Fundus photo.
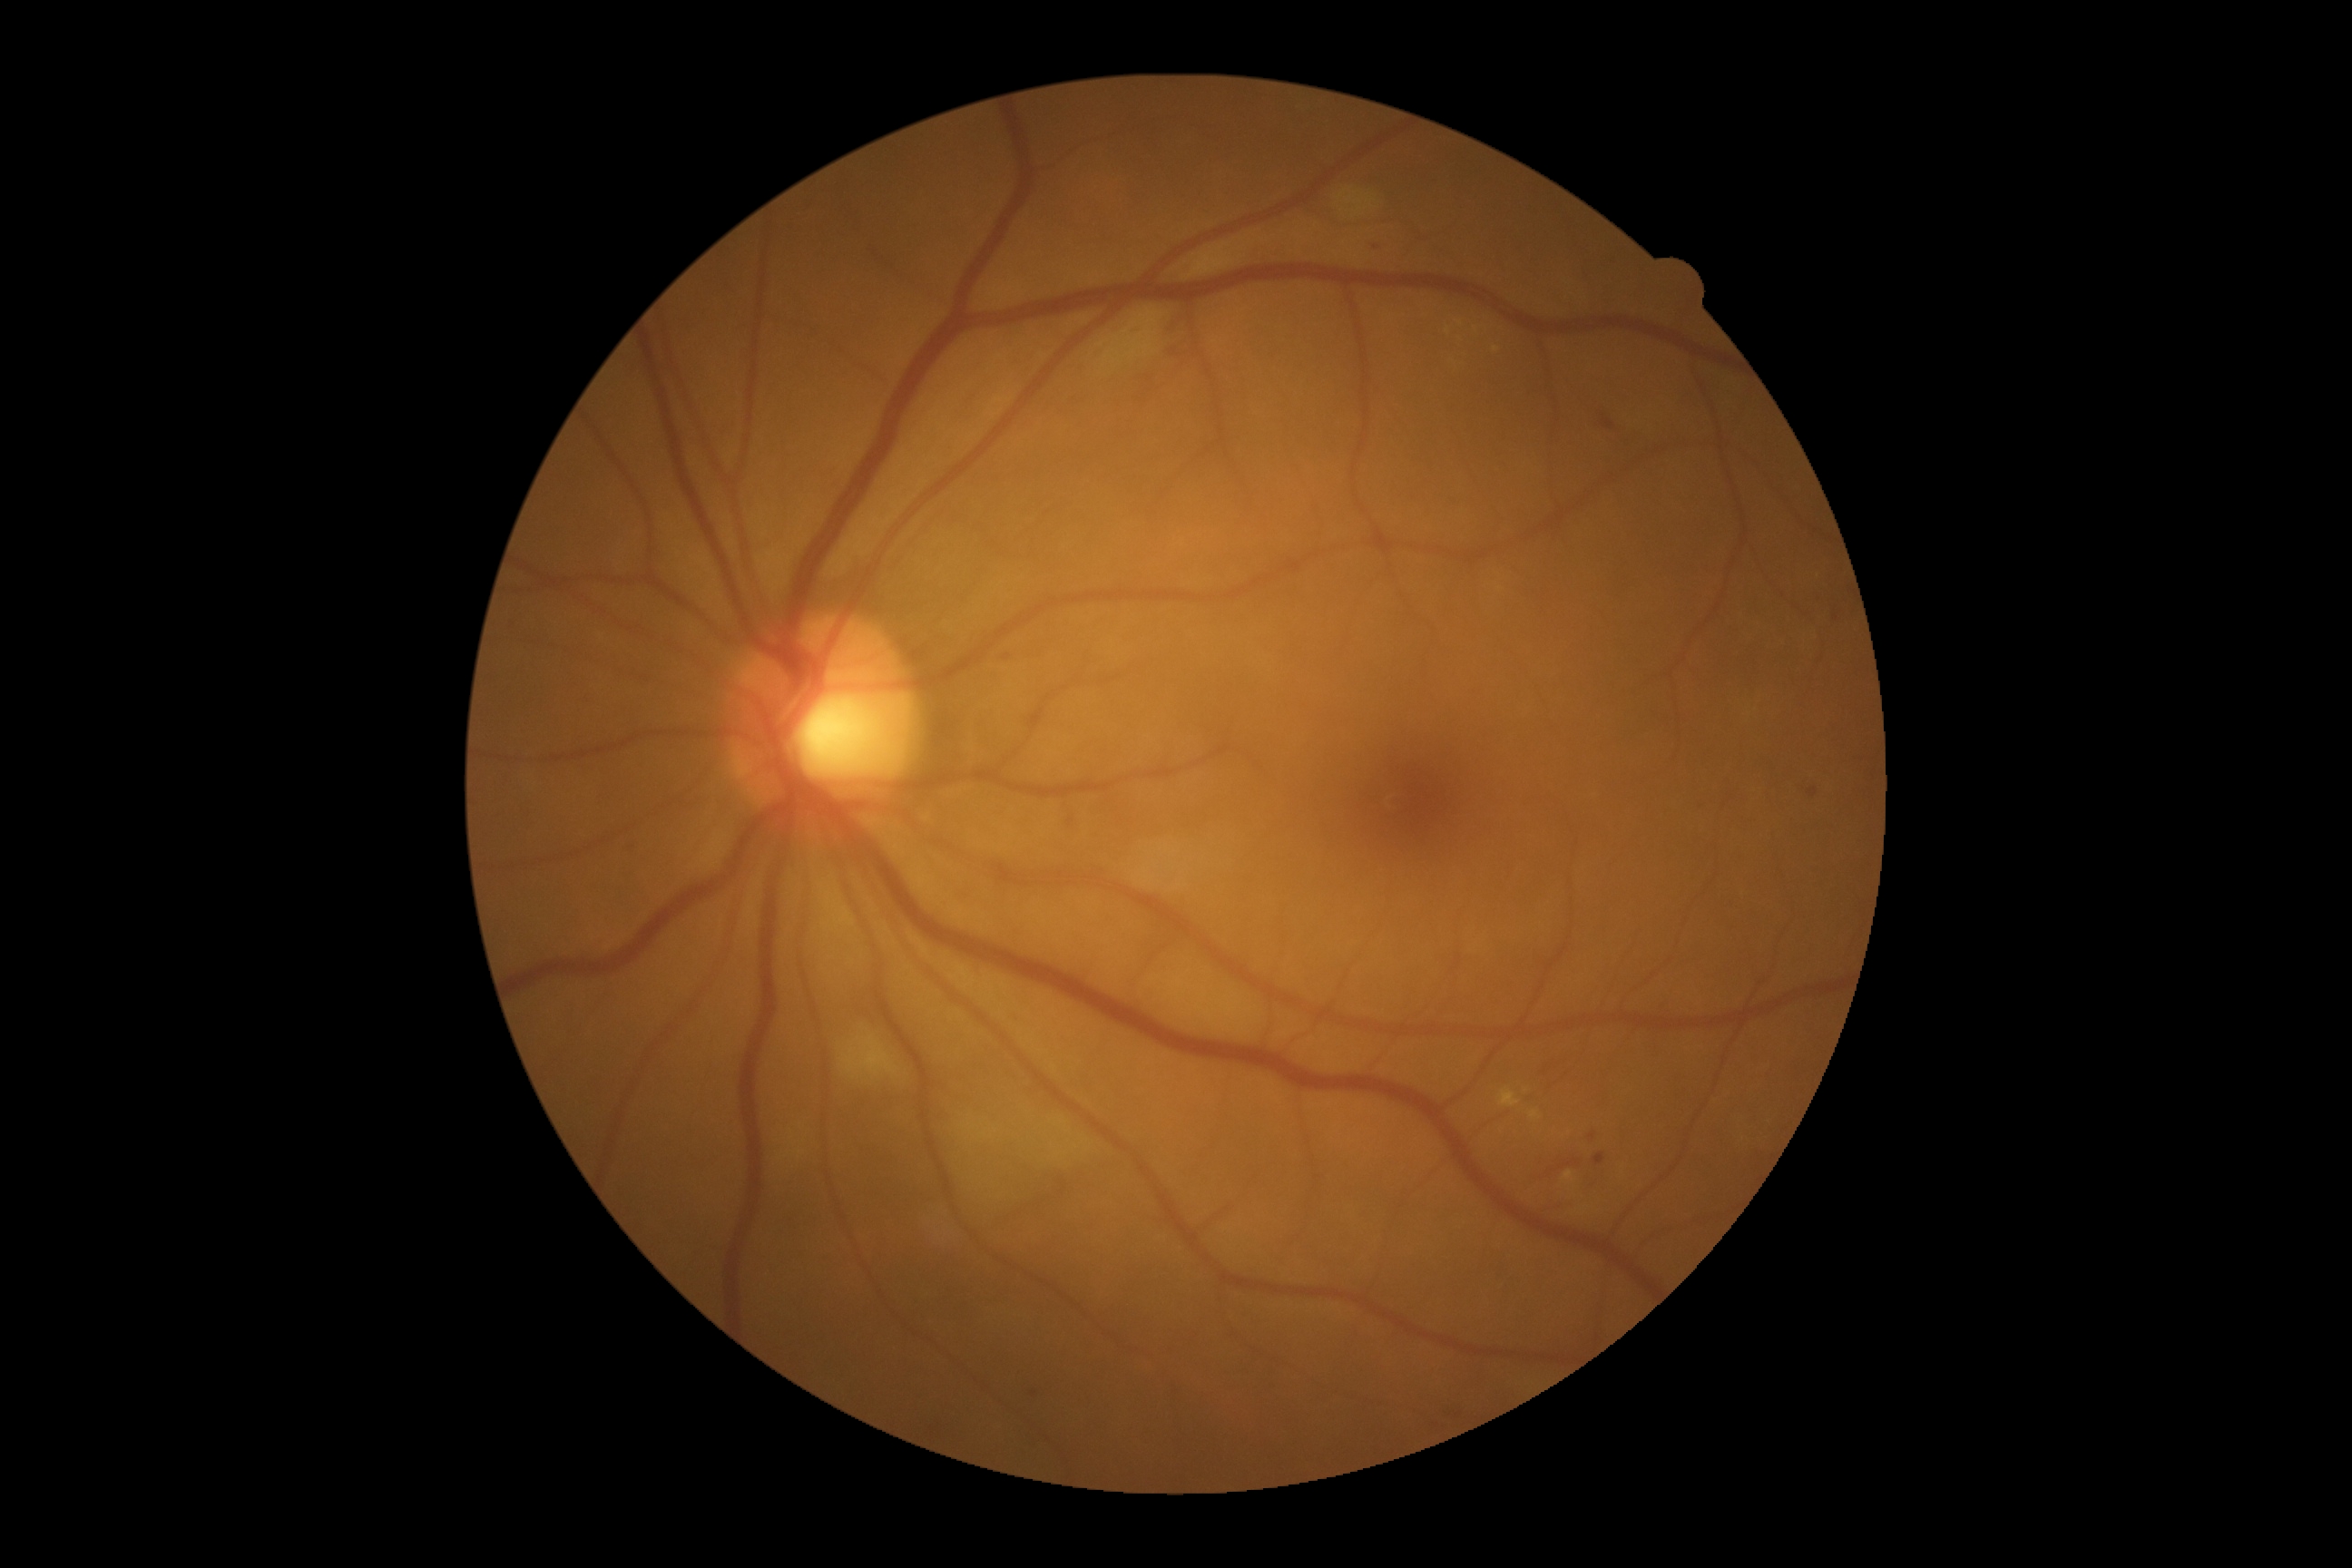

Diabetic retinopathy (DR) is grade 2 (moderate NPDR)
A subset of detected lesions:
hard exudates (EXs) (continued): left=1529, top=1110, right=1542, bottom=1121, left=1498, top=1088, right=1522, bottom=1108, left=1563, top=1171, right=1574, bottom=1182
Small EXs near (1461, 325), (1527, 1091), (1448, 331), (1476, 330), (1496, 349)
microaneurysms (MAs): absent
soft exudates (SEs): left=832, top=1019, right=921, bottom=1106, left=1338, top=188, right=1377, bottom=220
Small SEs near (1500, 589)
hemorrhages (HEs): left=1139, top=373, right=1166, bottom=406, left=622, top=839, right=638, bottom=854, left=1132, top=322, right=1148, bottom=338, left=580, top=691, right=598, bottom=710, left=1371, top=240, right=1389, bottom=253, left=1004, top=656, right=1012, bottom=662, left=1602, top=415, right=1616, bottom=429, left=1560, top=1159, right=1580, bottom=1170, left=1808, top=789, right=1818, bottom=798, left=1166, top=311, right=1195, bottom=360, left=1589, top=1133, right=1596, bottom=1141, left=1594, top=1153, right=1607, bottom=1166
Small HEs near (1553, 1170), (1034, 1393)